Color fundus image. 2352x1568: 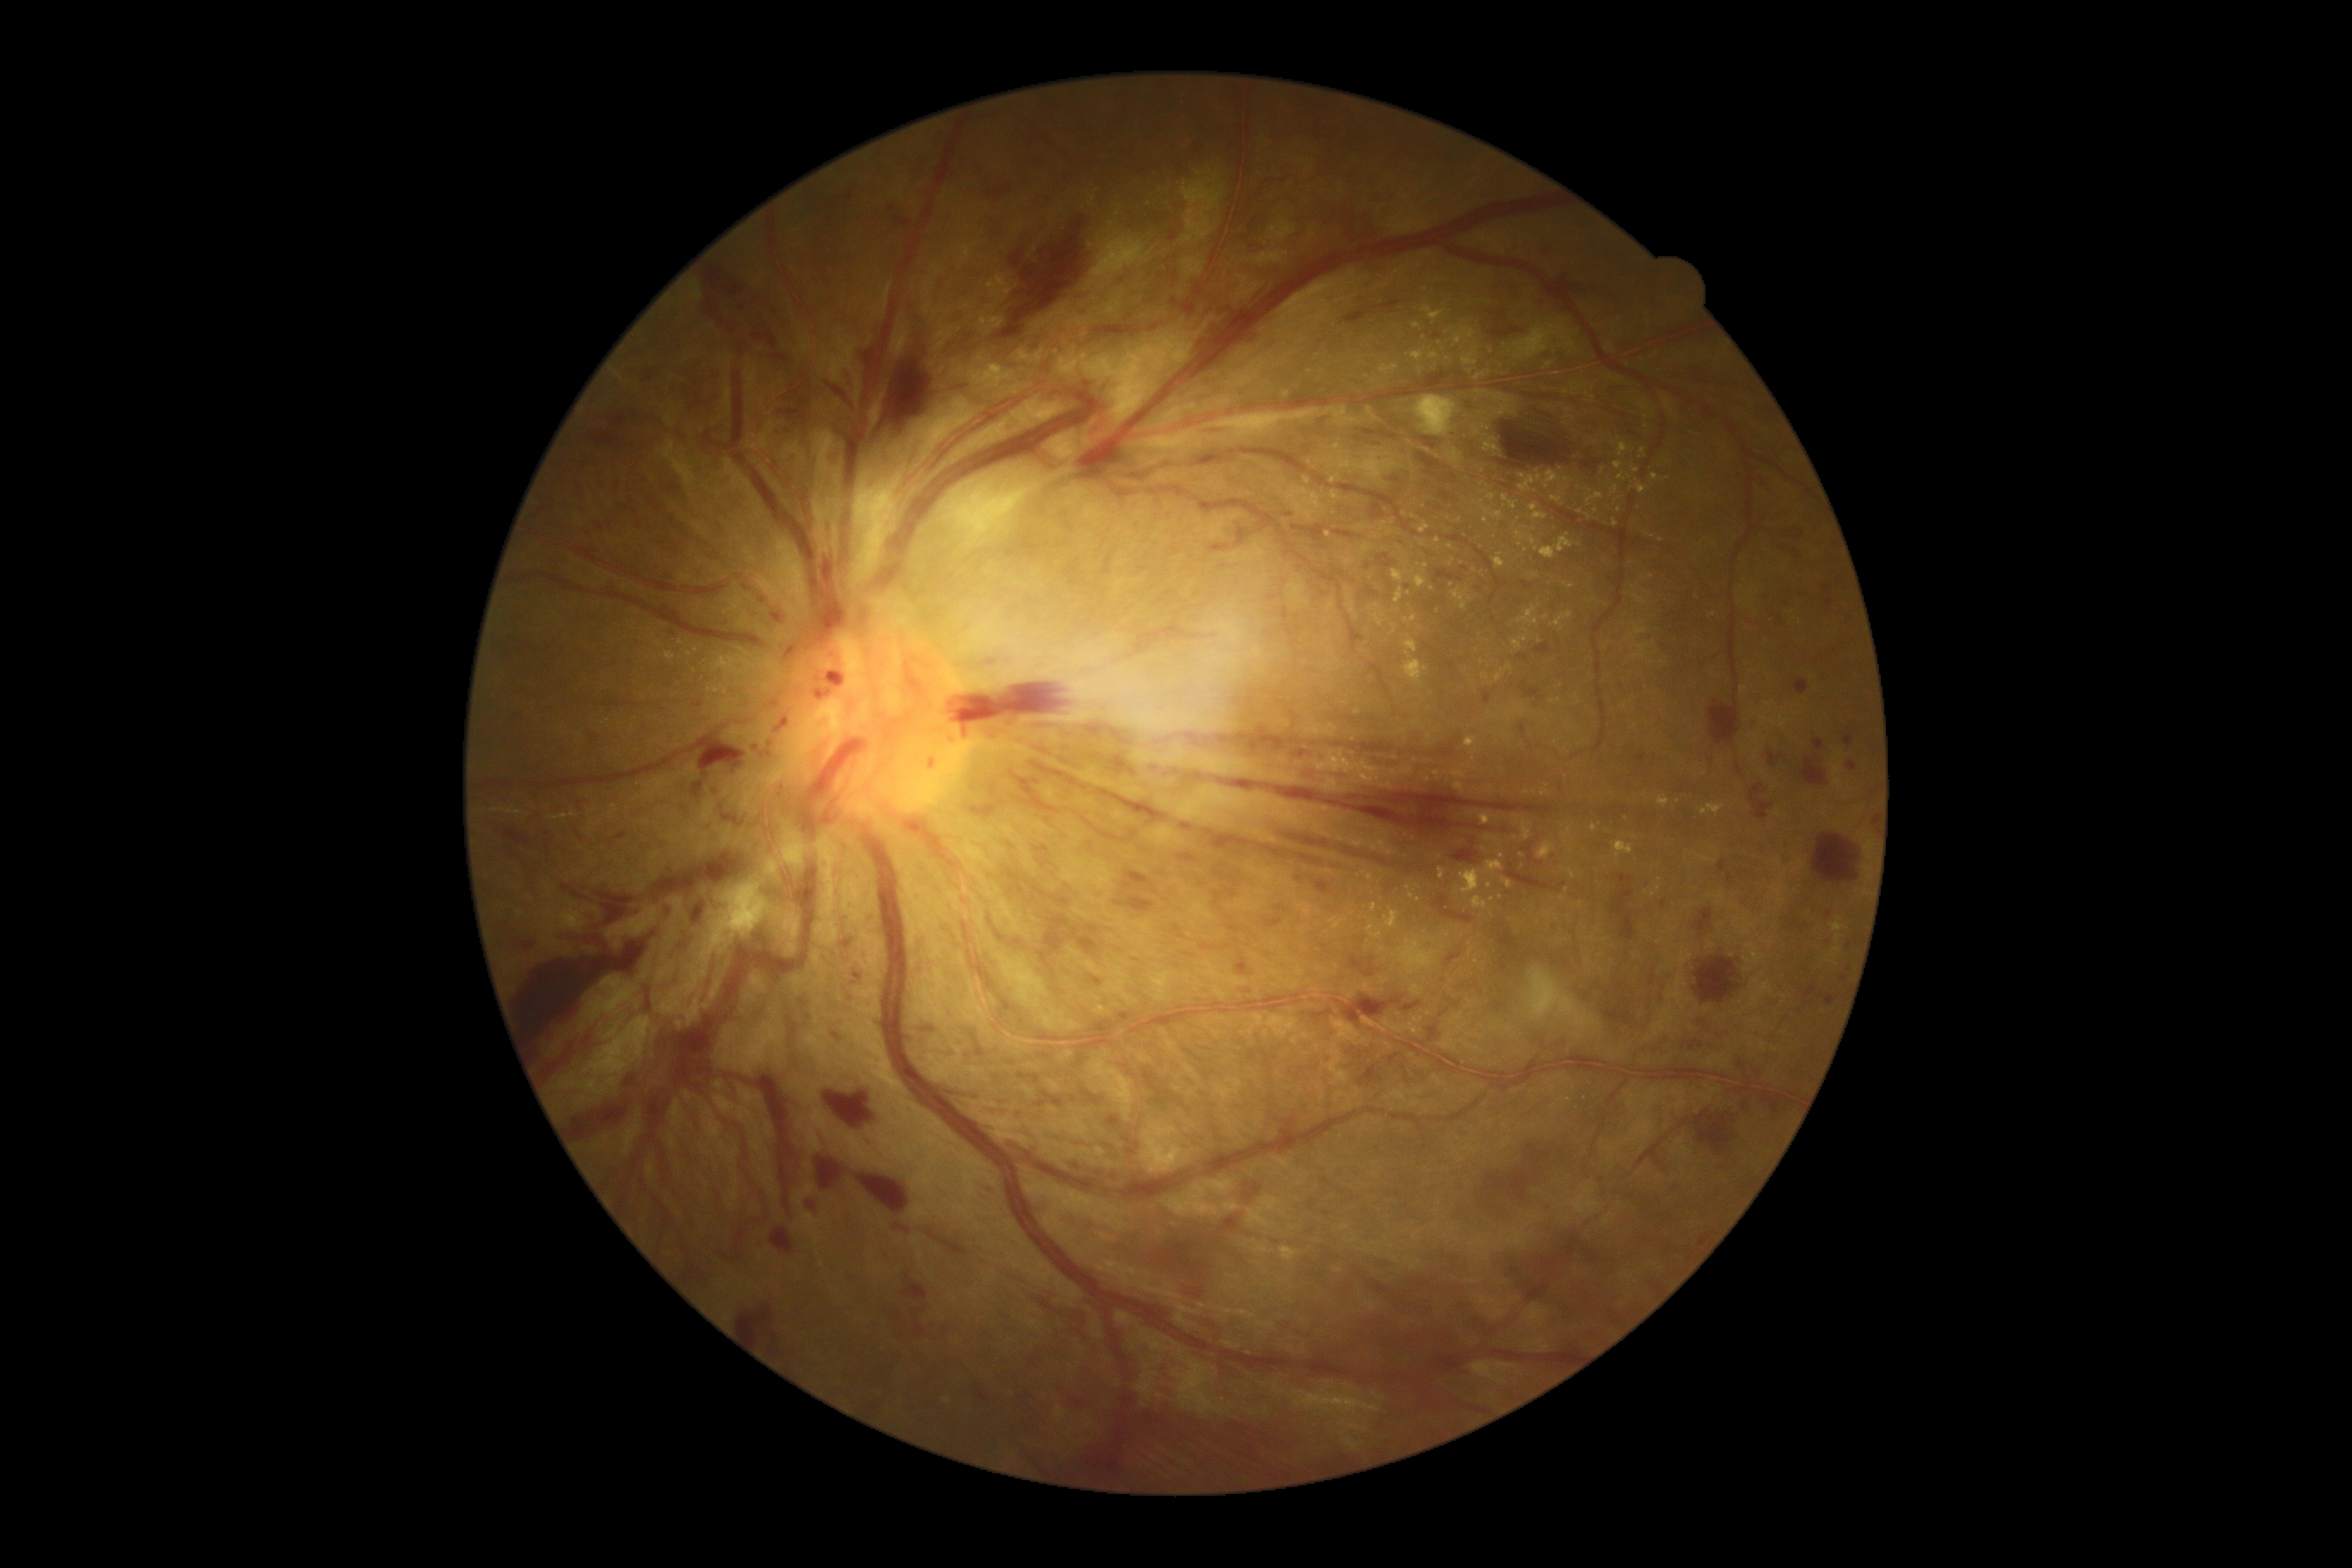

DR grade: 4 (PDR)
Lesions identified (partial list):
- HEs (partial): [x1=1070, y1=929, x2=1099, y2=955]; [x1=823, y1=556, x2=840, y2=589]; [x1=1201, y1=945, x2=1213, y2=952]; [x1=914, y1=1321, x2=924, y2=1338]; [x1=950, y1=685, x2=1065, y2=735]; [x1=1730, y1=1115, x2=1736, y2=1124]; [x1=1517, y1=654, x2=1528, y2=661]; [x1=986, y1=1125, x2=1003, y2=1132]; [x1=928, y1=1230, x2=969, y2=1258]; [x1=1815, y1=738, x2=1823, y2=750]; [x1=1524, y1=1240, x2=1567, y2=1285]; [x1=936, y1=267, x2=953, y2=291]; [x1=1435, y1=570, x2=1461, y2=584]; [x1=1237, y1=525, x2=1249, y2=548]; [x1=1333, y1=530, x2=1357, y2=539]; [x1=591, y1=432, x2=608, y2=446]; [x1=1825, y1=995, x2=1837, y2=1007]; [x1=1057, y1=1400, x2=1354, y2=1483]
- Smaller HEs around 1472:843; 755:748
- EXs (partial): [x1=1485, y1=438, x2=1502, y2=453]; [x1=549, y1=814, x2=568, y2=821]; [x1=1454, y1=326, x2=1476, y2=345]; [x1=1019, y1=350, x2=1027, y2=358]; [x1=1240, y1=1313, x2=1249, y2=1318]; [x1=1634, y1=644, x2=1648, y2=659]; [x1=1304, y1=477, x2=1311, y2=486]; [x1=1454, y1=781, x2=1466, y2=795]; [x1=666, y1=652, x2=677, y2=661]; [x1=1631, y1=467, x2=1639, y2=474]; [x1=1514, y1=322, x2=1571, y2=362]
- Smaller EXs around 1310:462; 1501:898; 1409:594; 690:654; 1562:900; 986:284; 998:280; 1502:857; 1053:351